Wide-field fundus photograph of an infant. 100° field of view (Phoenix ICON): 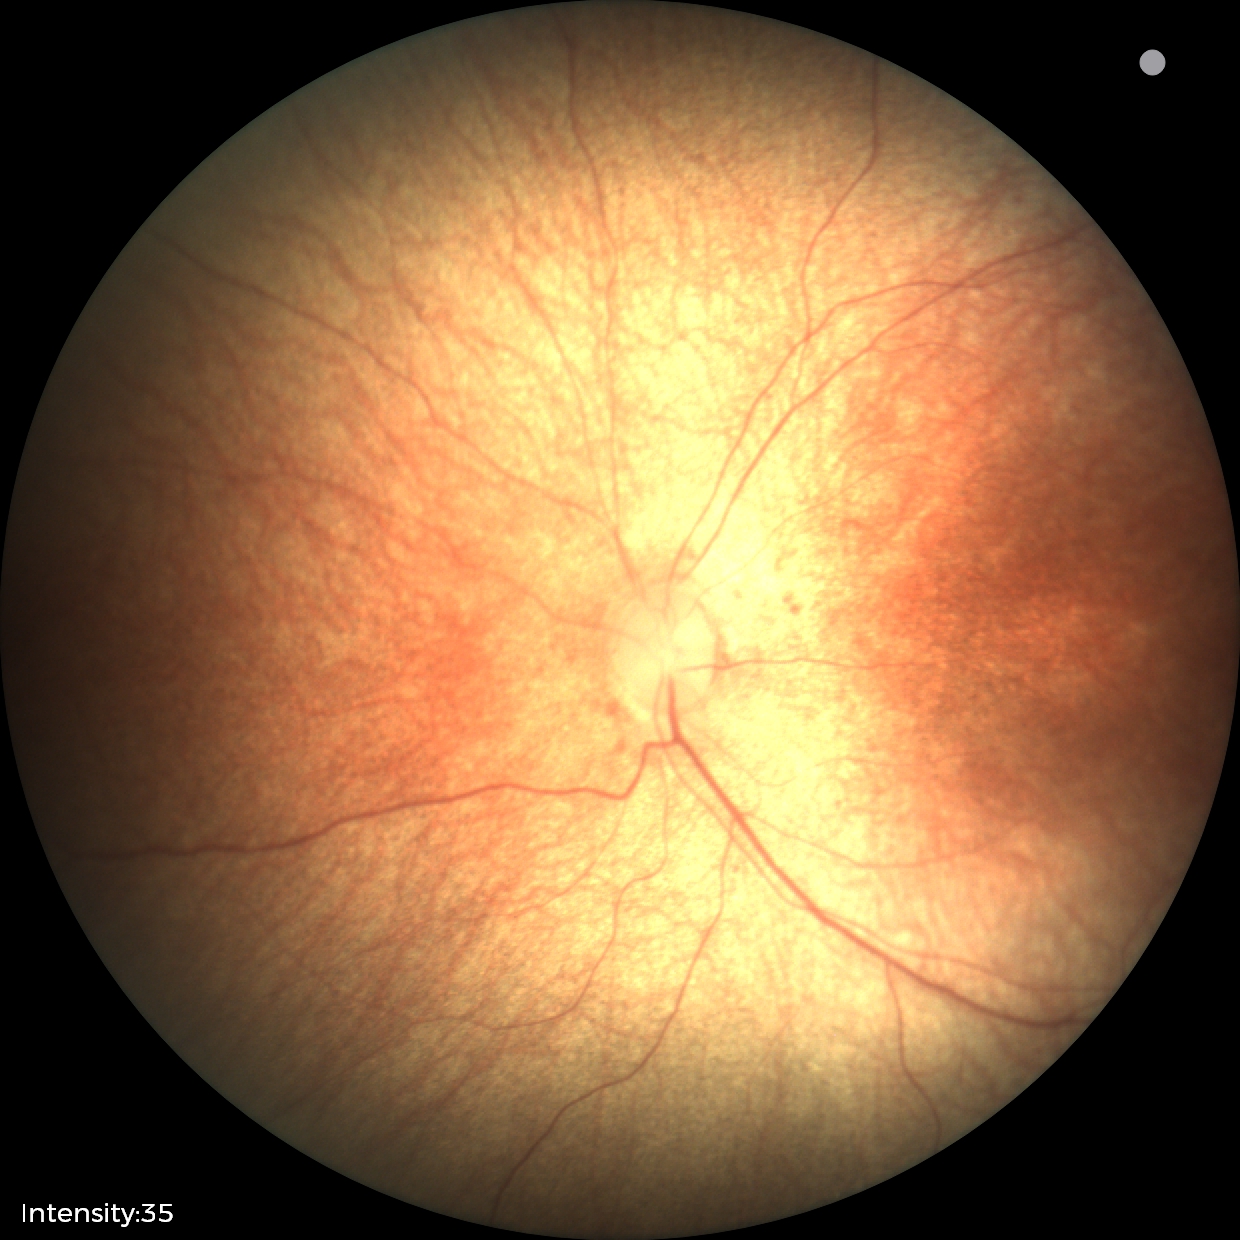
Physiological retinal appearance for postconceptual age.